Pediatric retinal photograph (wide-field); camera: Phoenix ICON (100° FOV); 1240 by 1240 pixels: 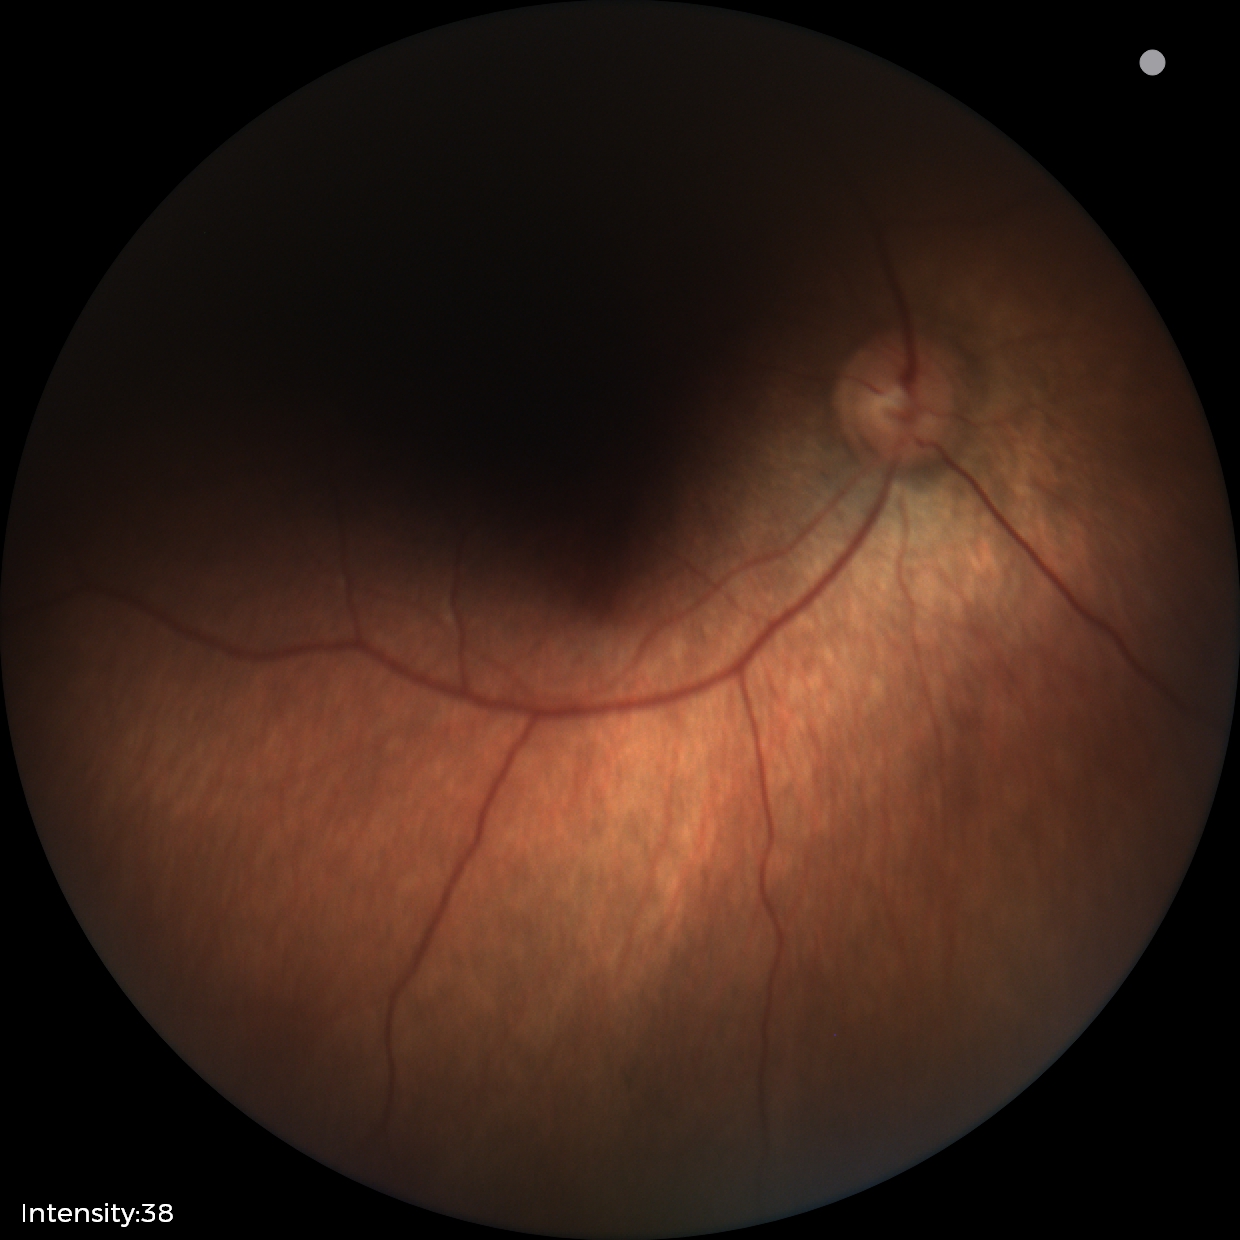
Screening diagnosis: physiological appearance with no retinal pathology.